Camera: NIDEK AFC-230 · modified Davis grading:
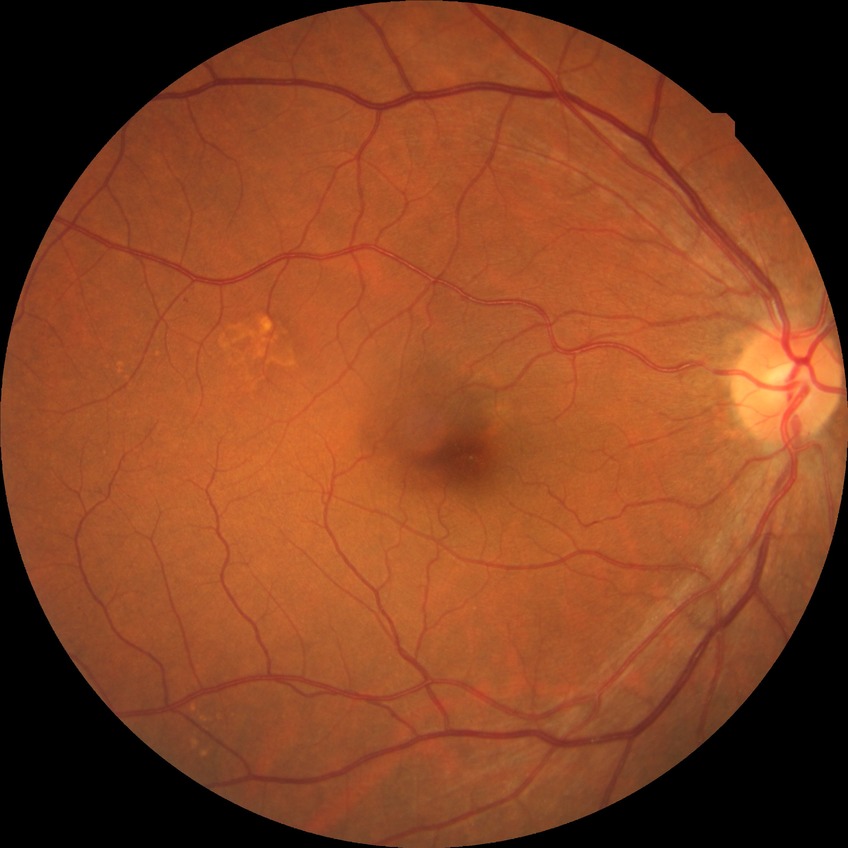 Diabetic retinopathy (DR) is NDR (no diabetic retinopathy).